2212 by 1659 pixels; retinal fundus photograph
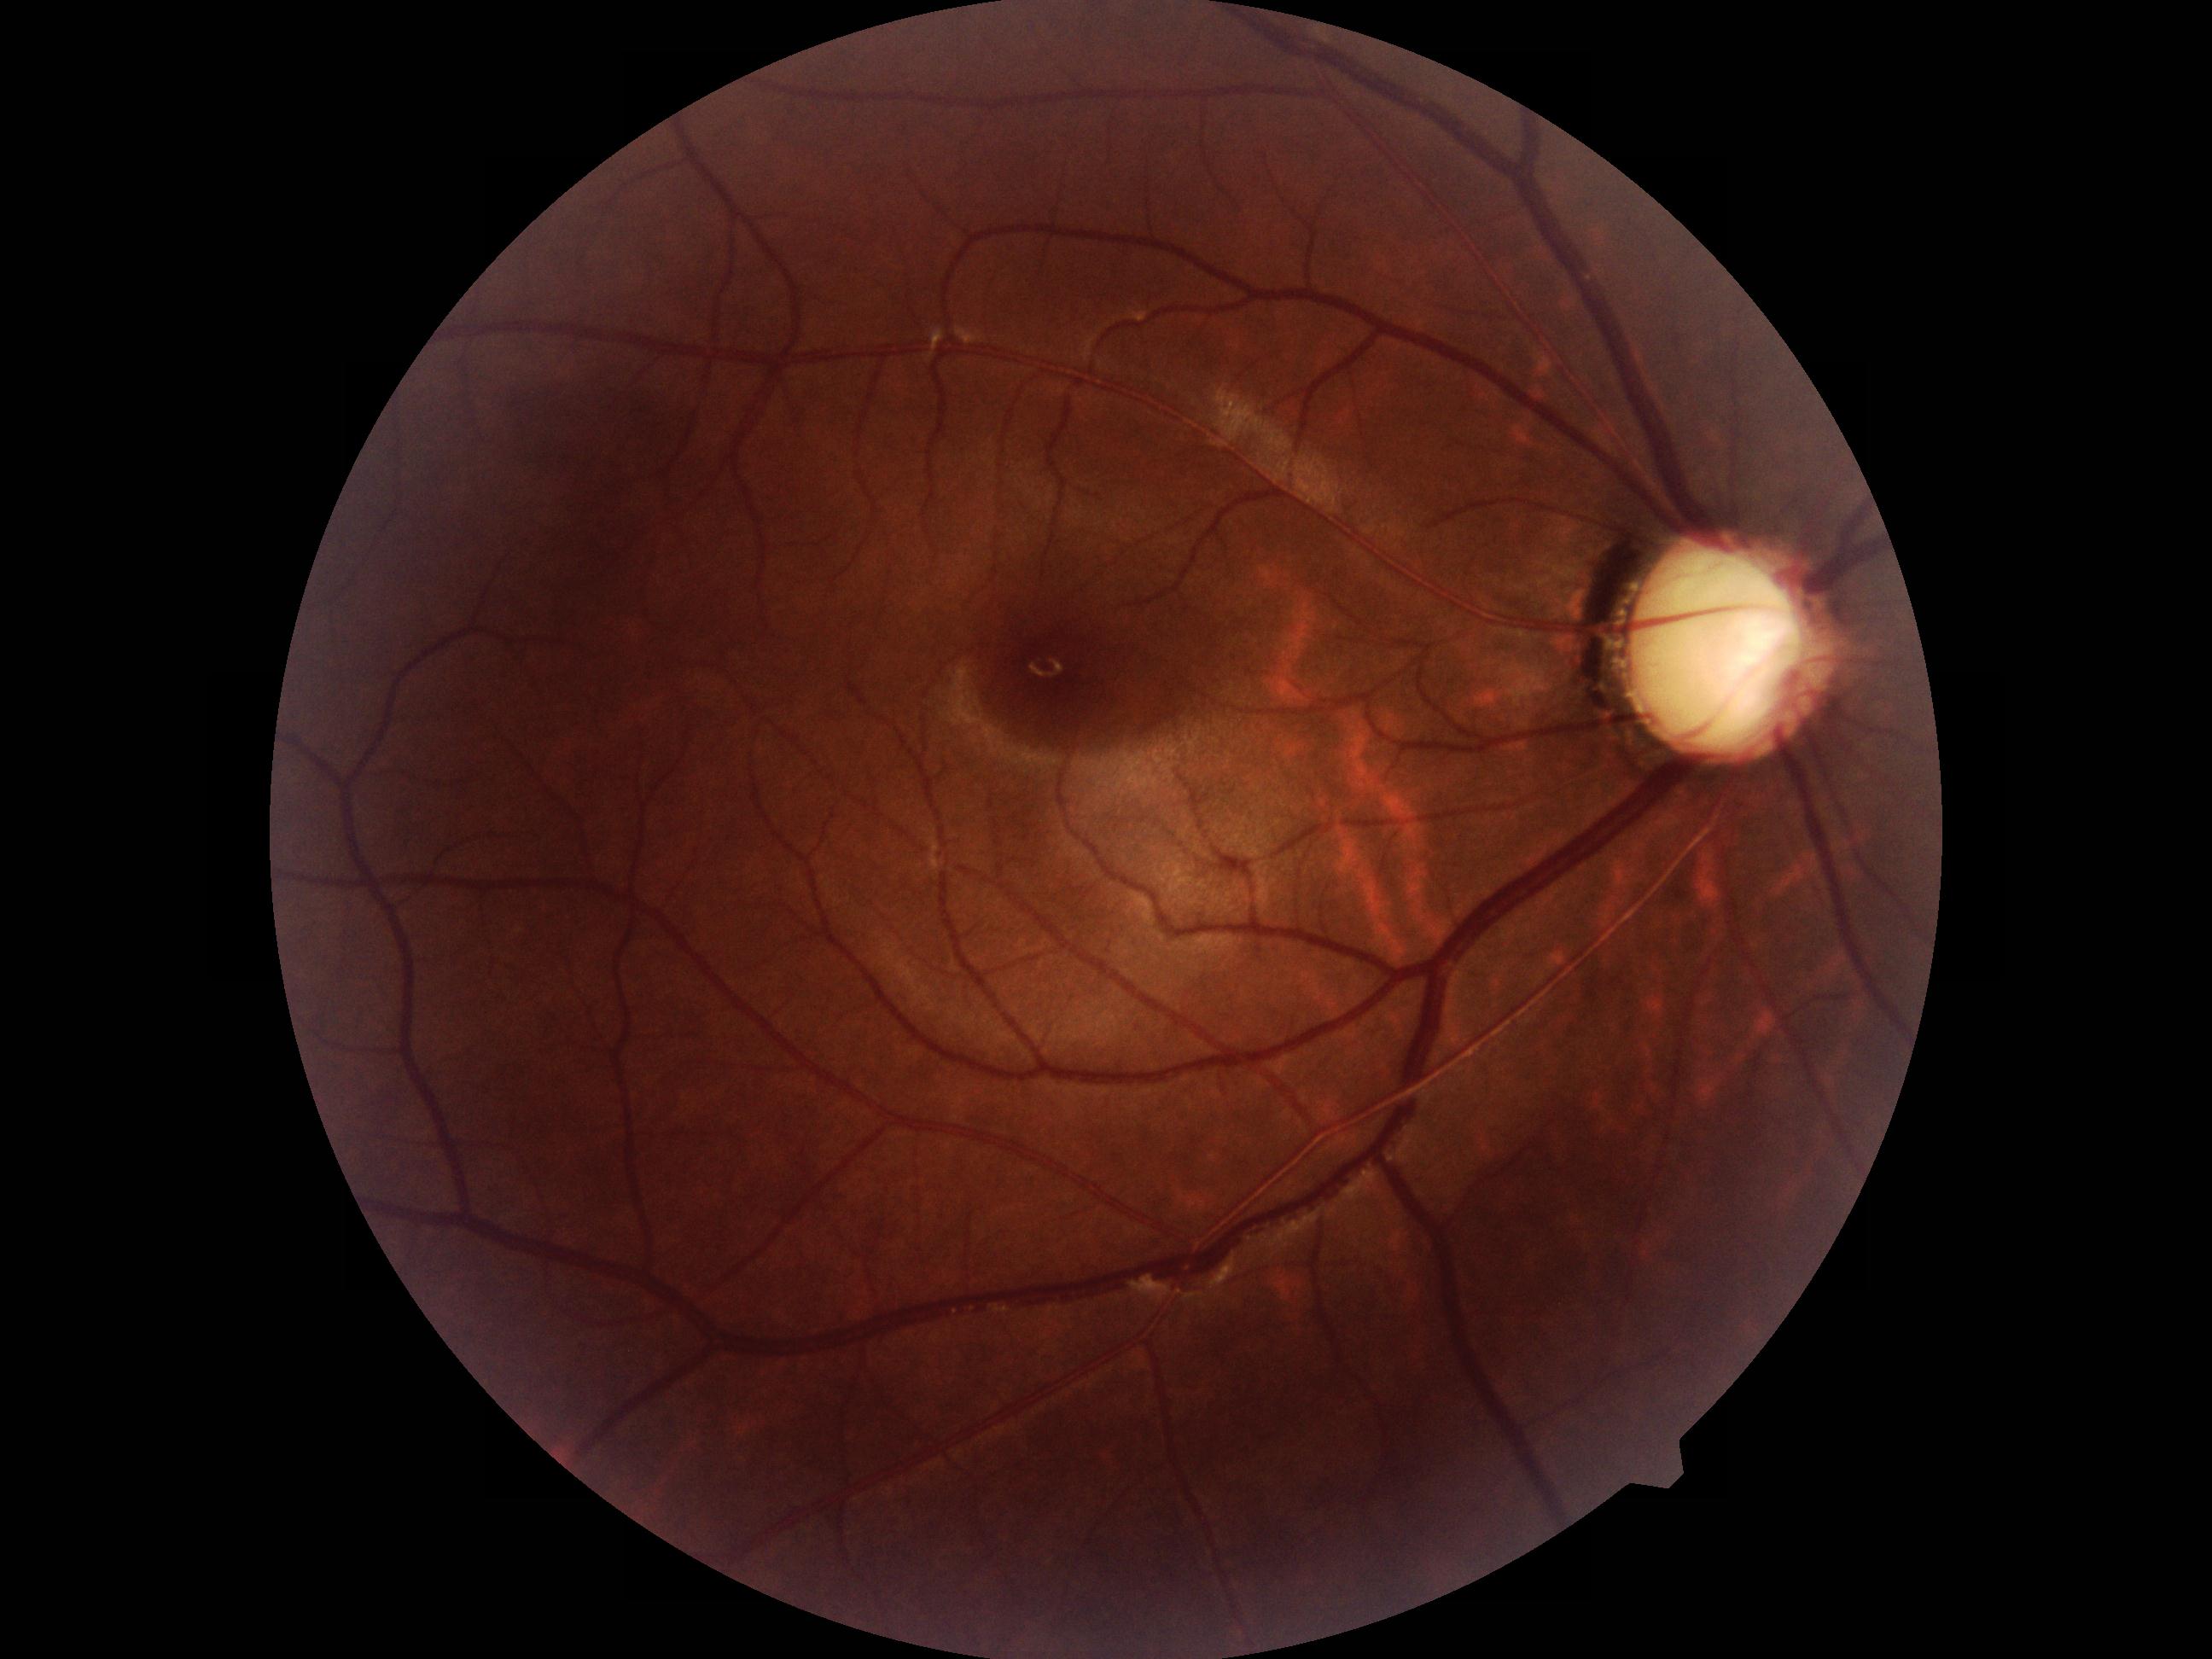 There is evidence of possible glaucoma.